Pediatric wide-field fundus photograph · image size 640x480.
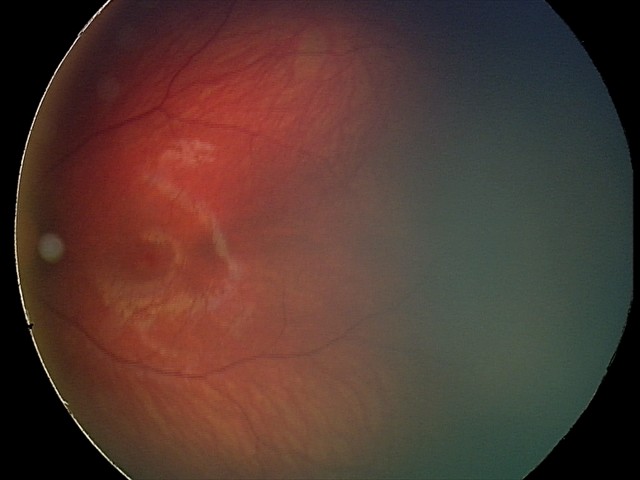 Screening series with retinal hemorrhages.